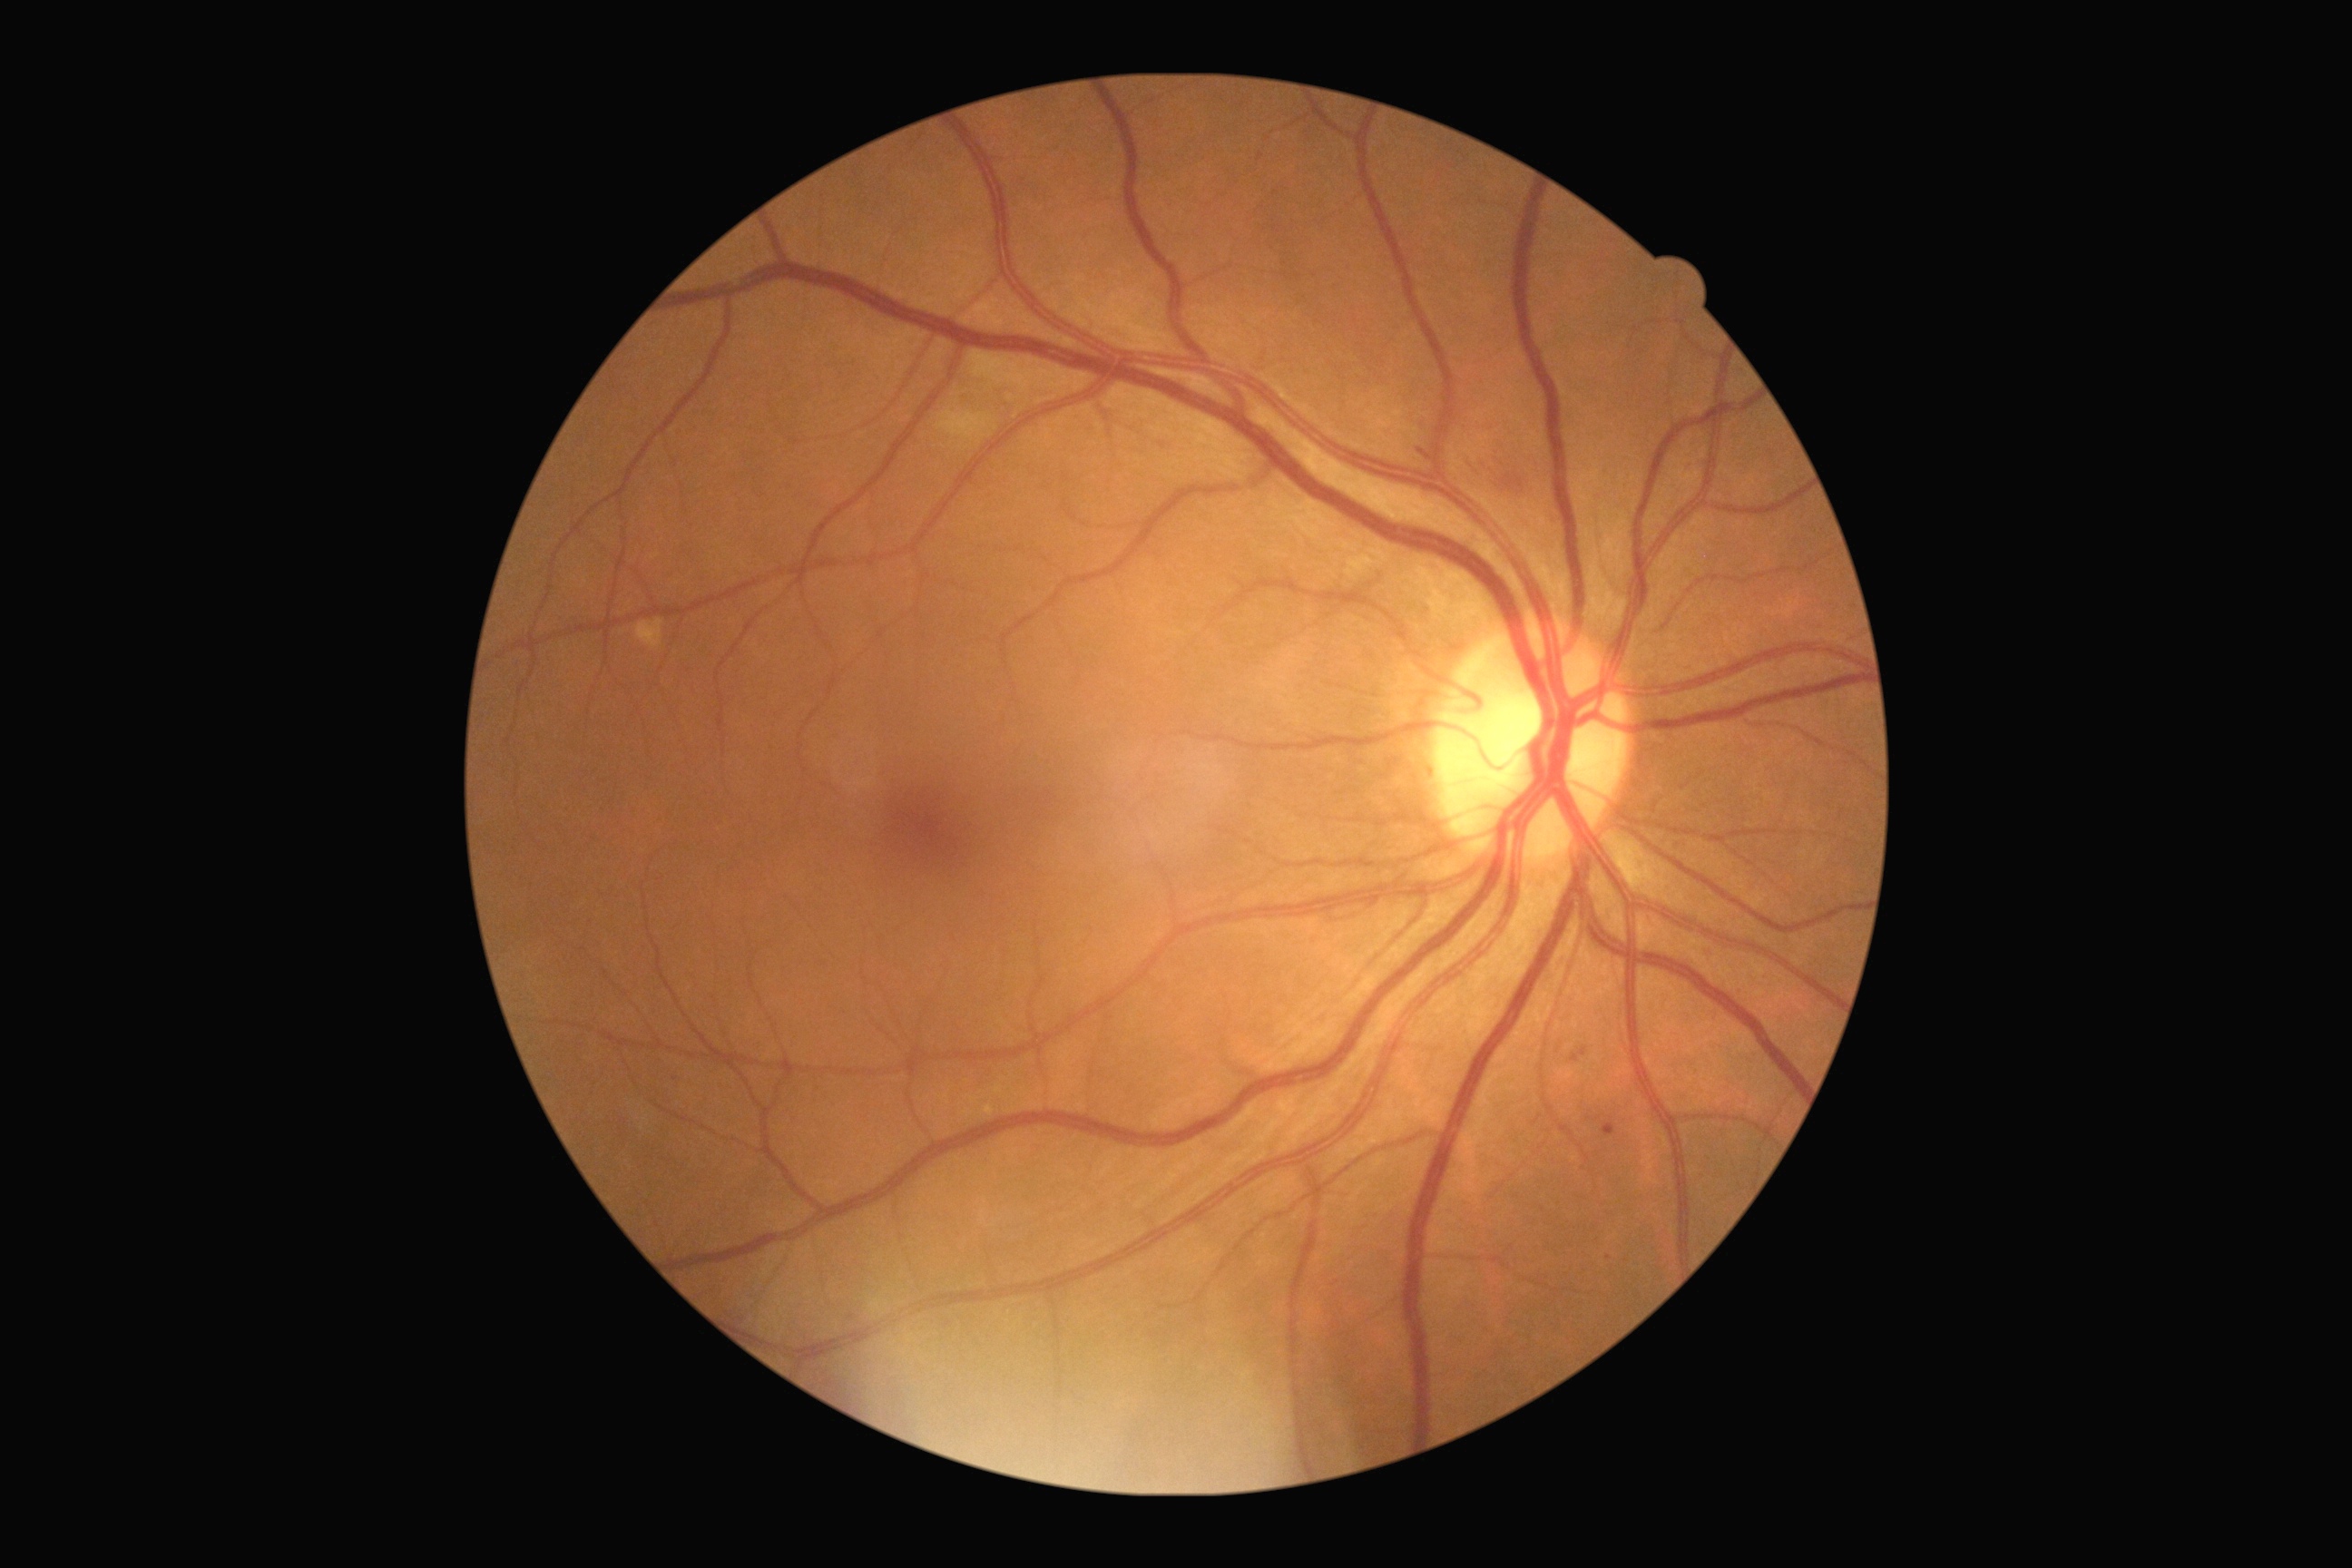

Diabetic retinopathy (DR) is moderate NPDR (grade 2). Microaneurysms (MAs) at <bbox>1703, 948, 1710, 956</bbox>; <bbox>1602, 1124, 1616, 1137</bbox>; <bbox>1571, 1048, 1589, 1063</bbox>. Small MAs approximately at (x=676, y=1081); (x=1609, y=1258). Soft exudates (SEs) at <bbox>937, 409, 992, 442</bbox>; <bbox>968, 351, 1004, 387</bbox>. Small SEs approximately at (x=1011, y=398). No hard exudates (EXs) identified. Hemorrhages (HEs) (partial list) at <bbox>1502, 475, 1524, 489</bbox>; <bbox>1469, 460, 1476, 471</bbox>; <bbox>1496, 460, 1511, 469</bbox>; <bbox>1482, 466, 1493, 473</bbox>; <bbox>1418, 451, 1431, 460</bbox>. Small HEs approximately at (x=1496, y=474).